Wide-field contact fundus photograph of an infant; acquired on the Phoenix ICON — 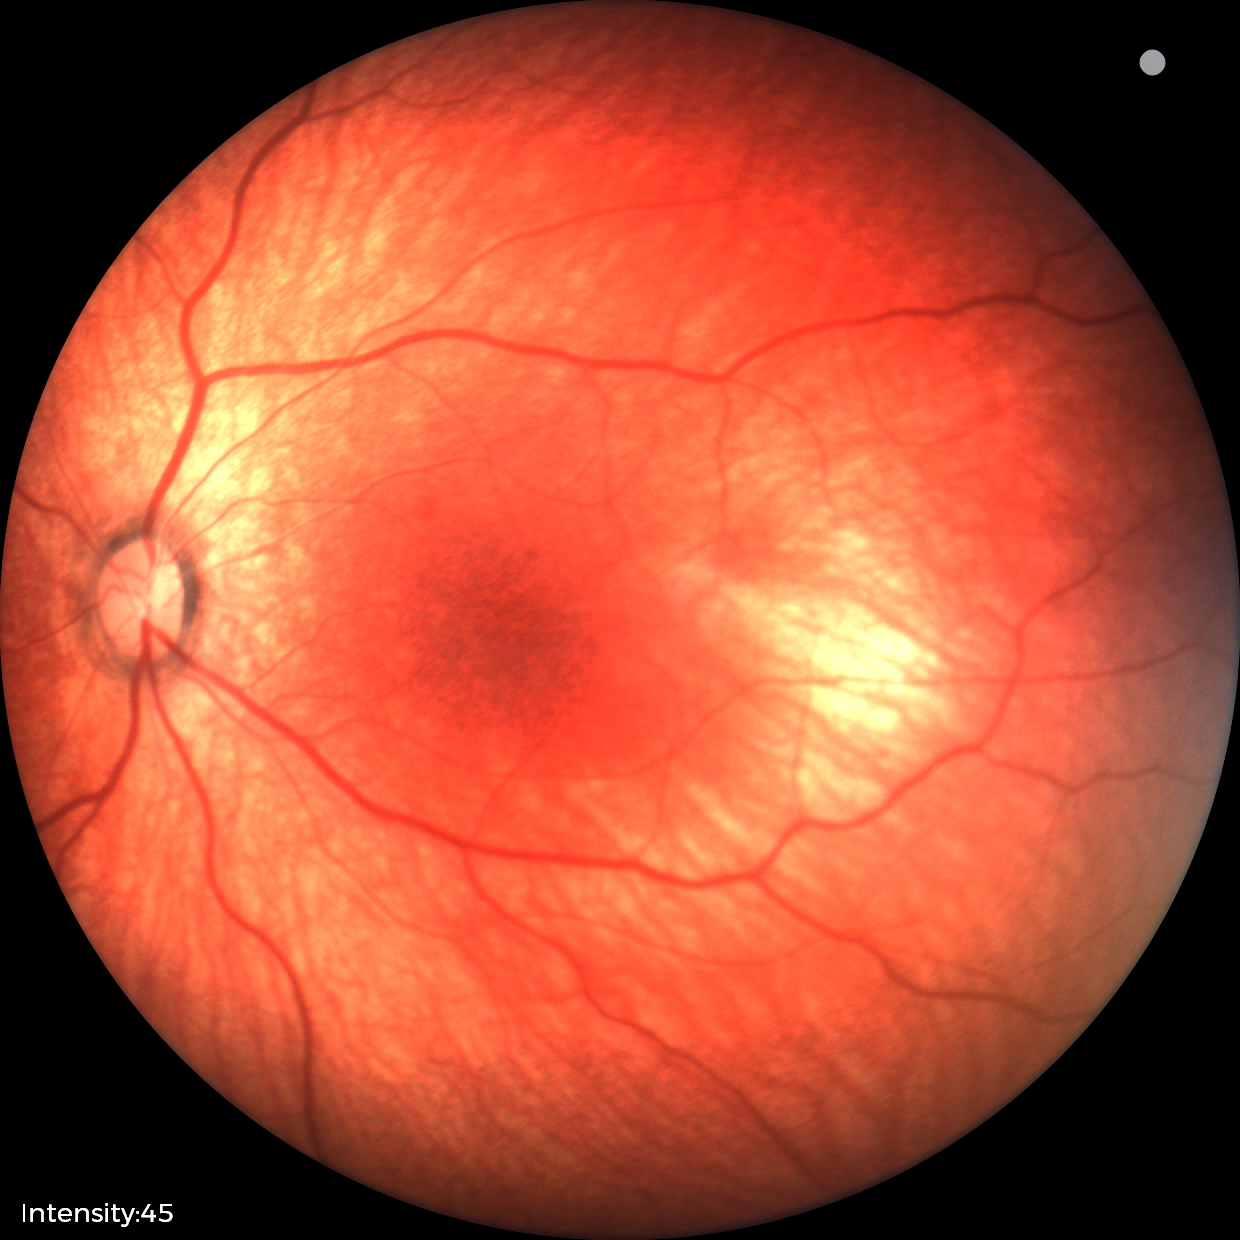

Screening diagnosis: physiological finding.